2352 x 1568 pixels
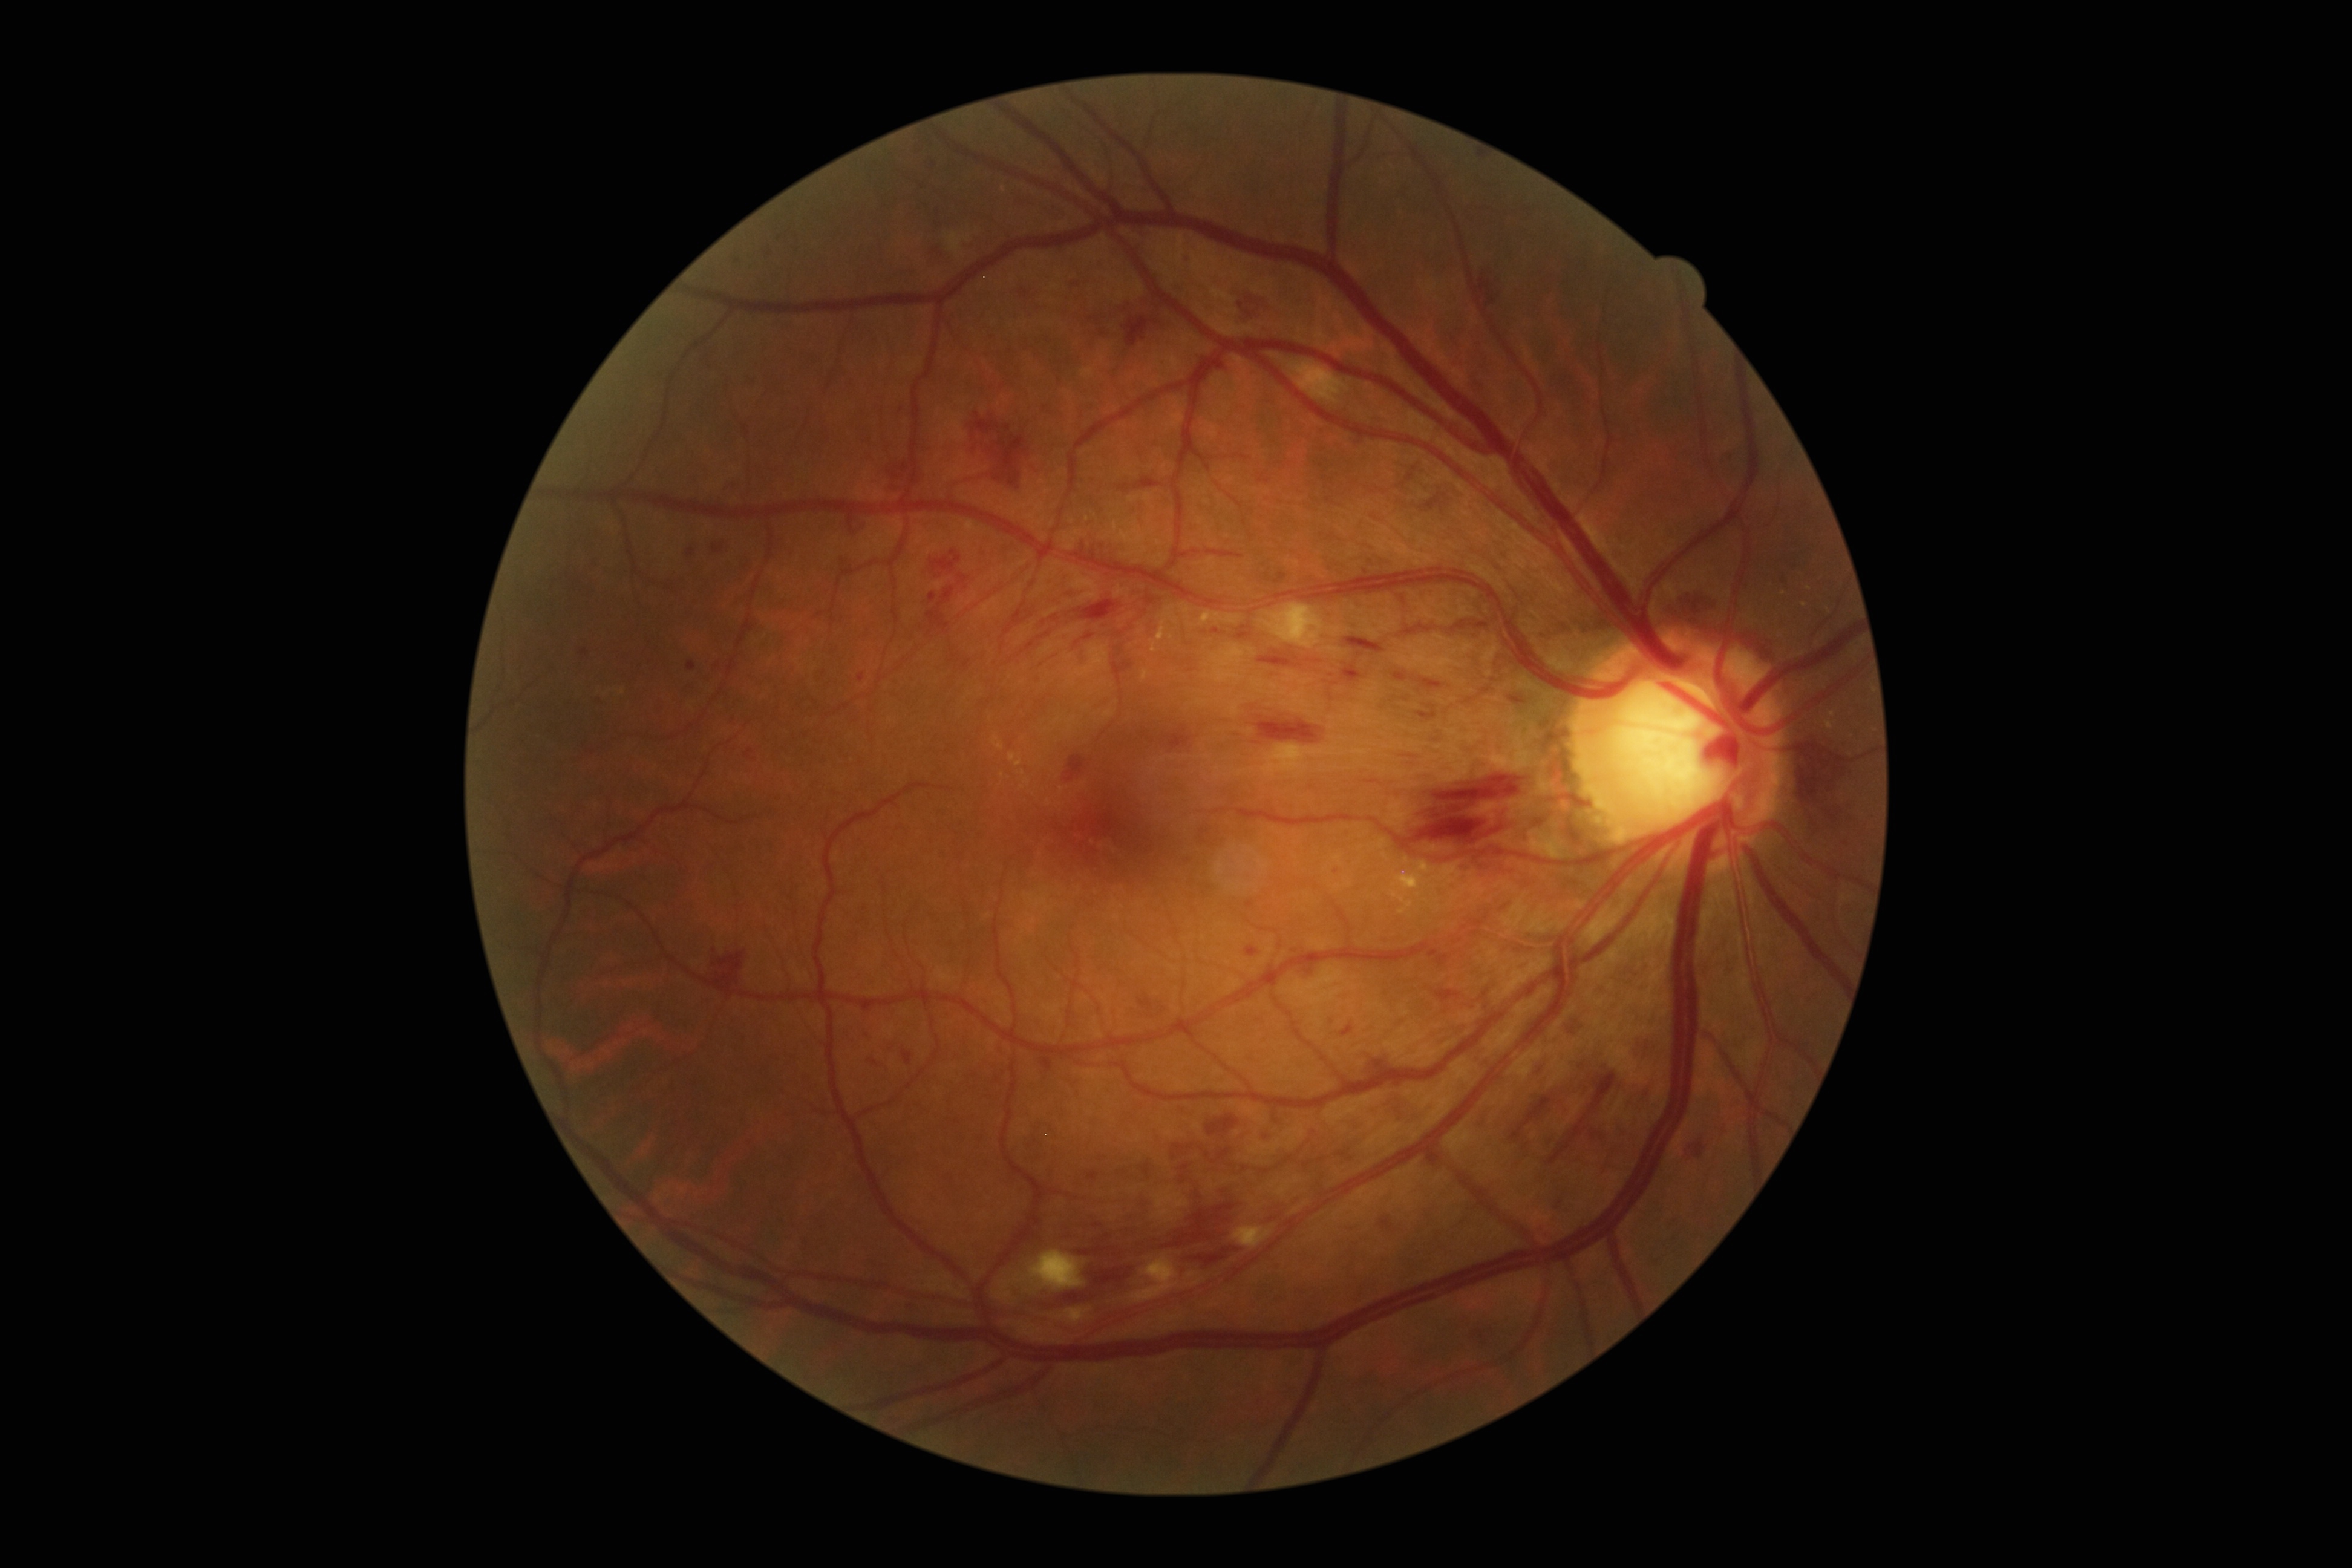 DR: 3 — more than 20 intraretinal hemorrhages in each of 4 quadrants, definite venous beading in 2 or more quadrants, or prominent intraretinal microvascular abnormalities in 1 or more quadrants, with no signs of proliferative retinopathy.
Disease class: non-proliferative diabetic retinopathy.